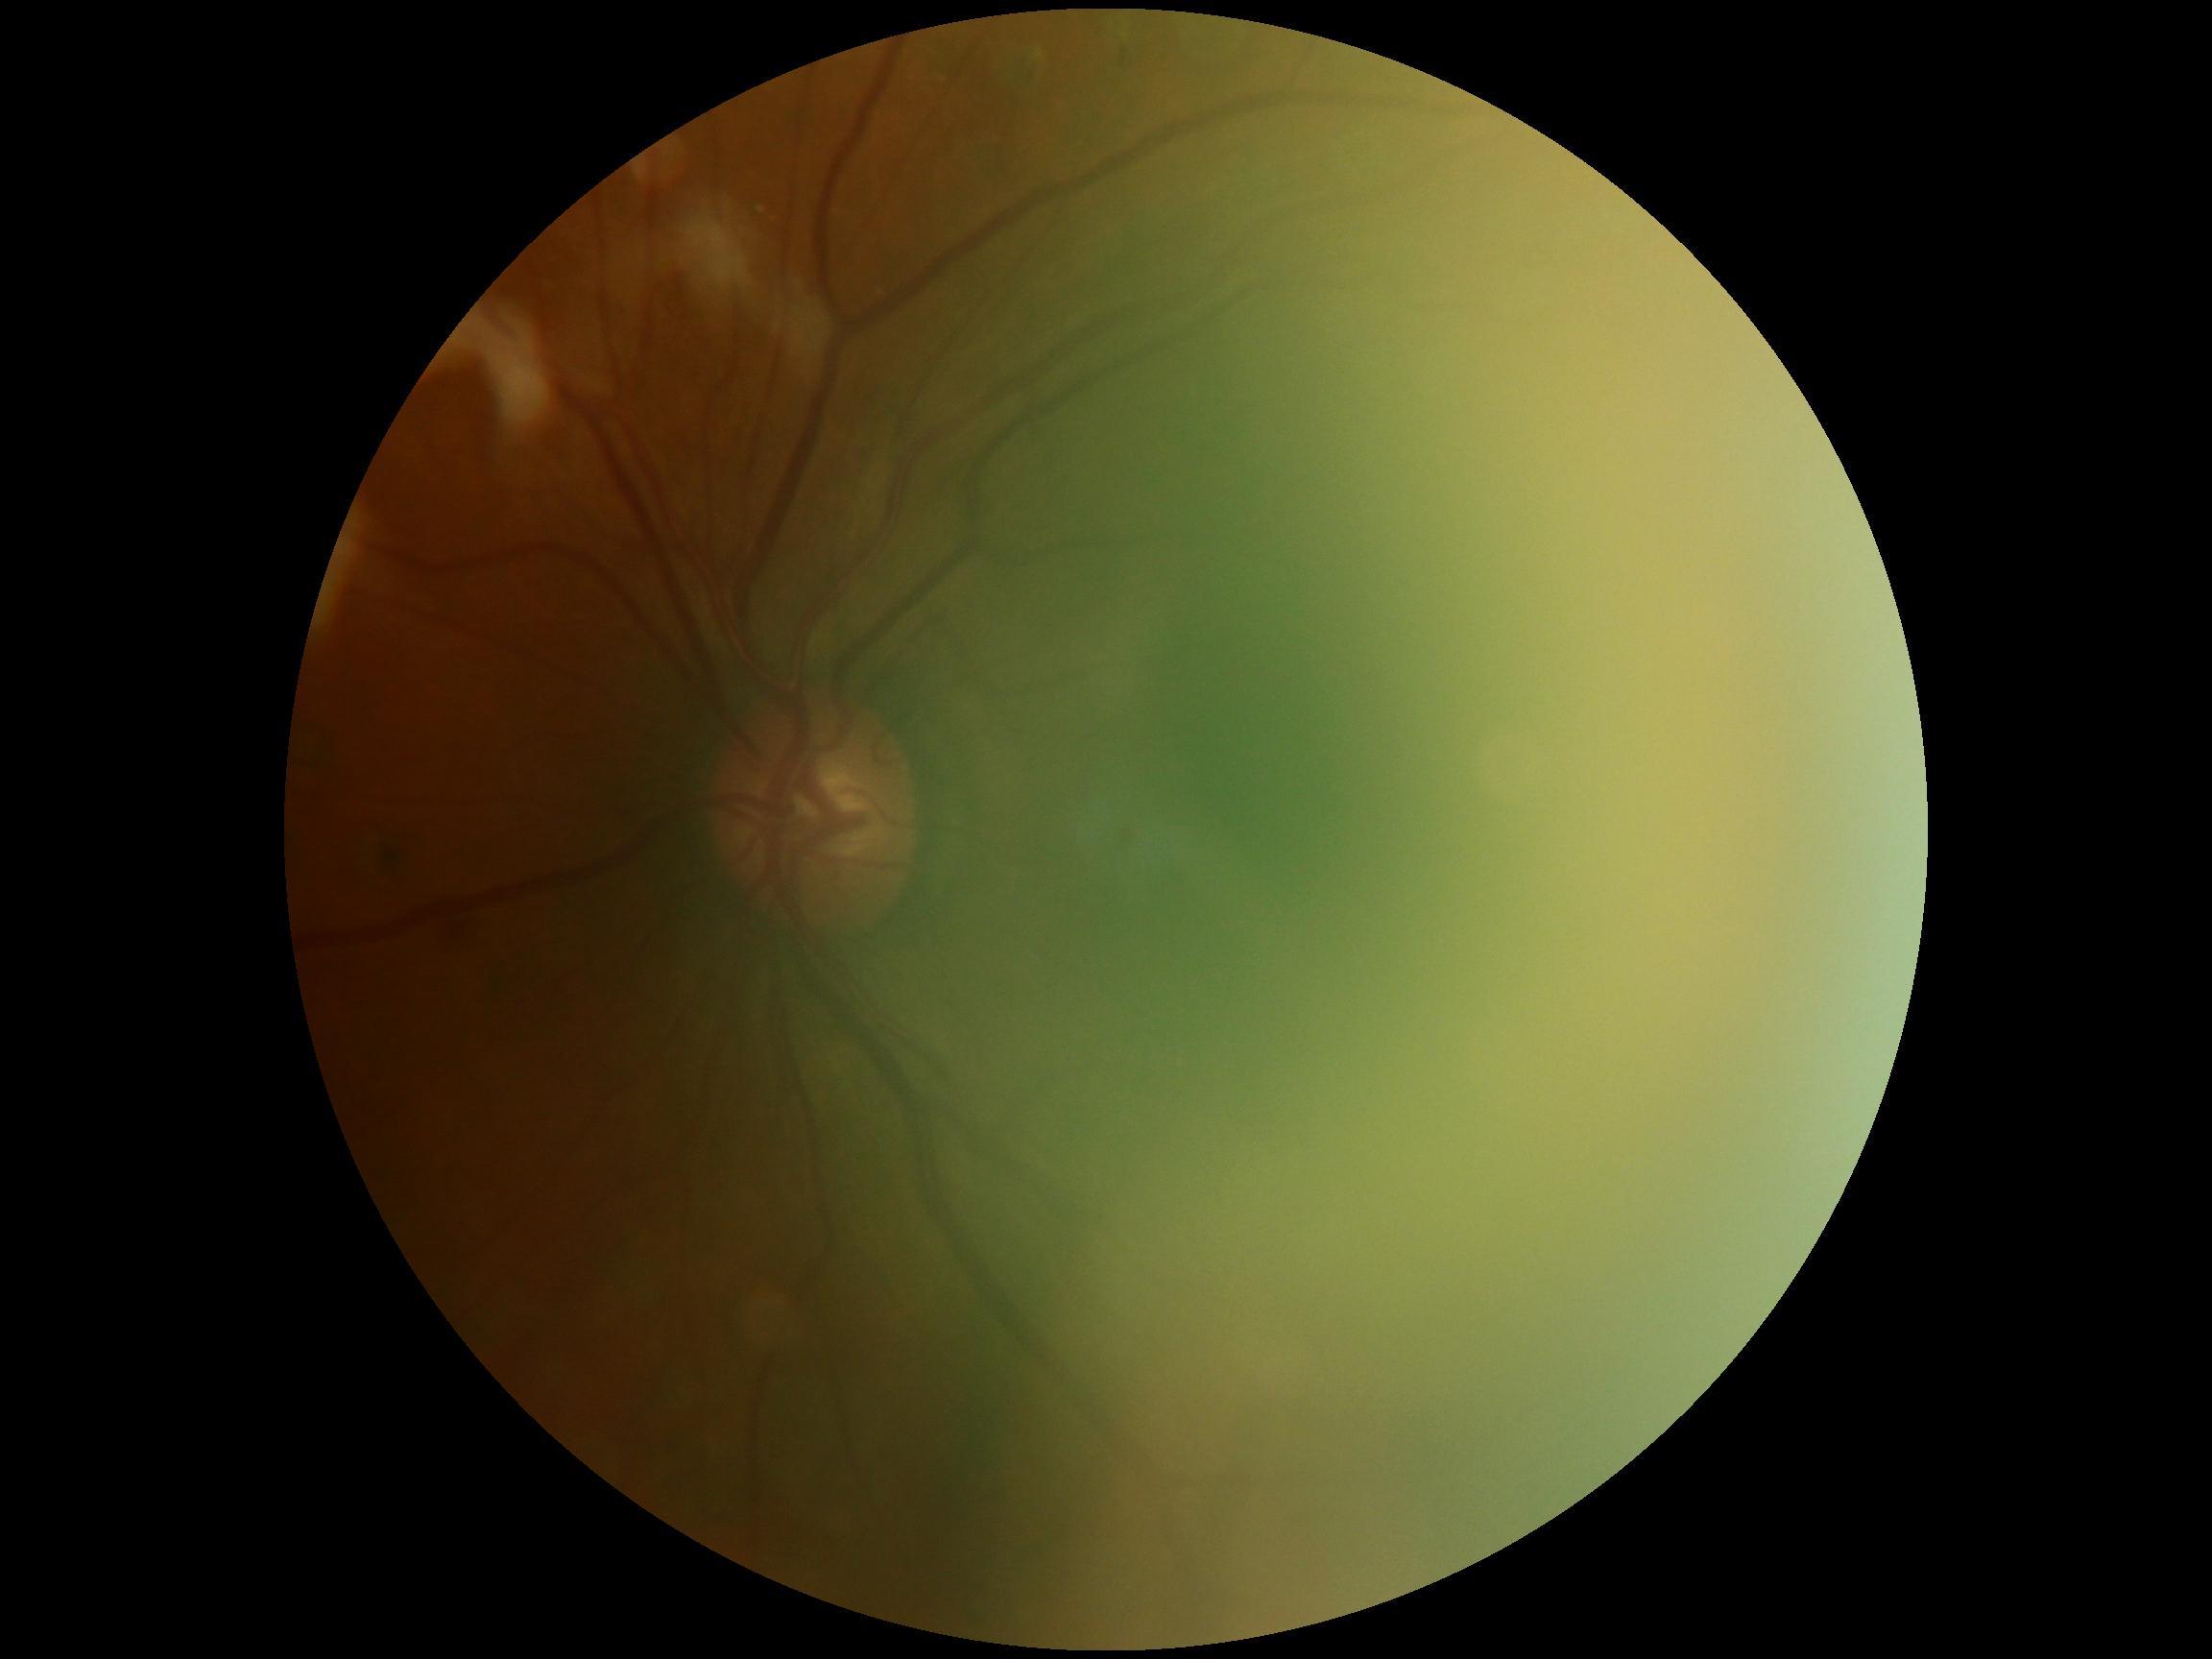 diabetic retinopathy (DR) = moderate NPDR (grade 2).